45° field of view, posterior pole color fundus photograph, nonmydriatic fundus photograph
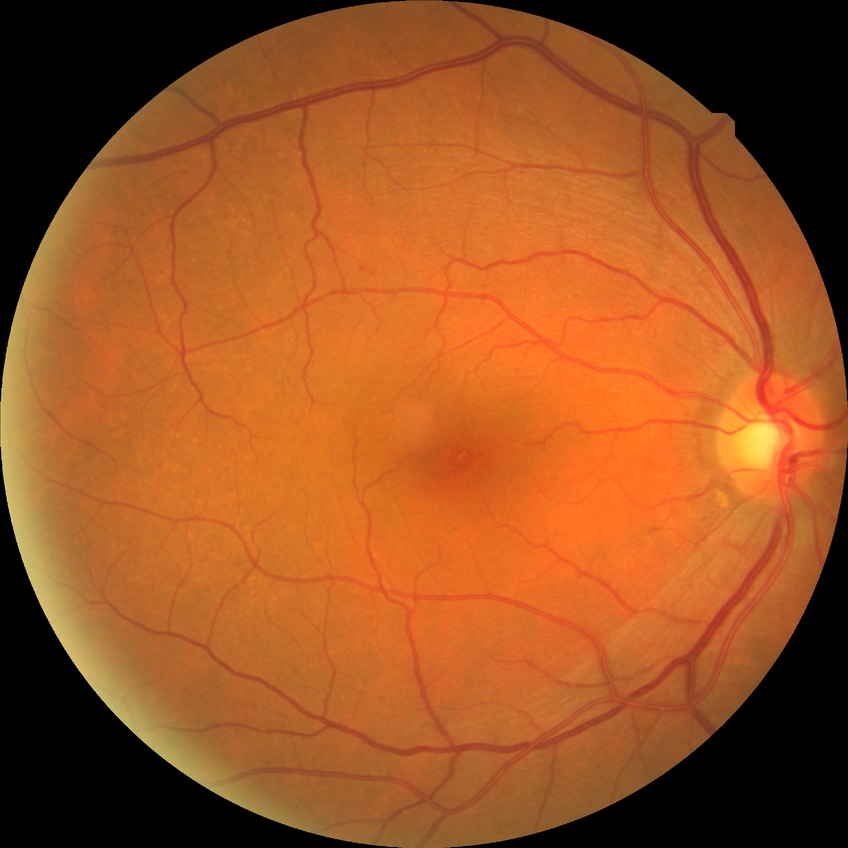

{"davis_grade": "SDR"}